DR severity per modified Davis staging.
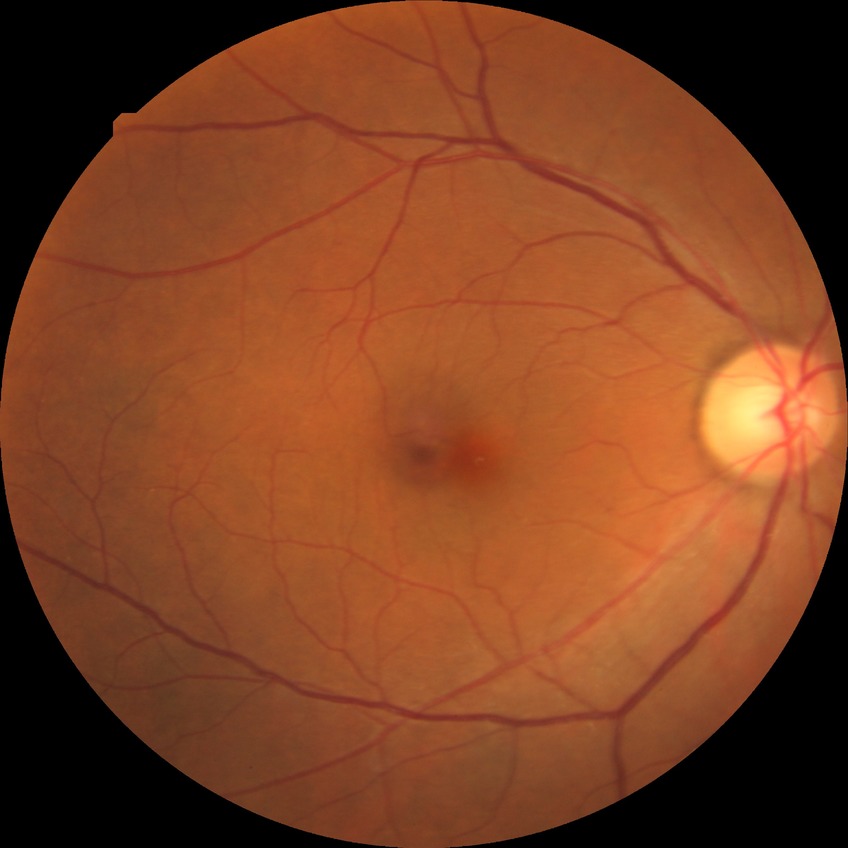 {
  "davis_grade": "no diabetic retinopathy"
}